Woman · non-mydriatic acquisition · axial length (AL) 22.77 mm · intraocular pressure 10 mmHg · pachymetry: 493 µm · FOV: 30 degrees · acquired with a Topcon TRC-NW400 · age 67: 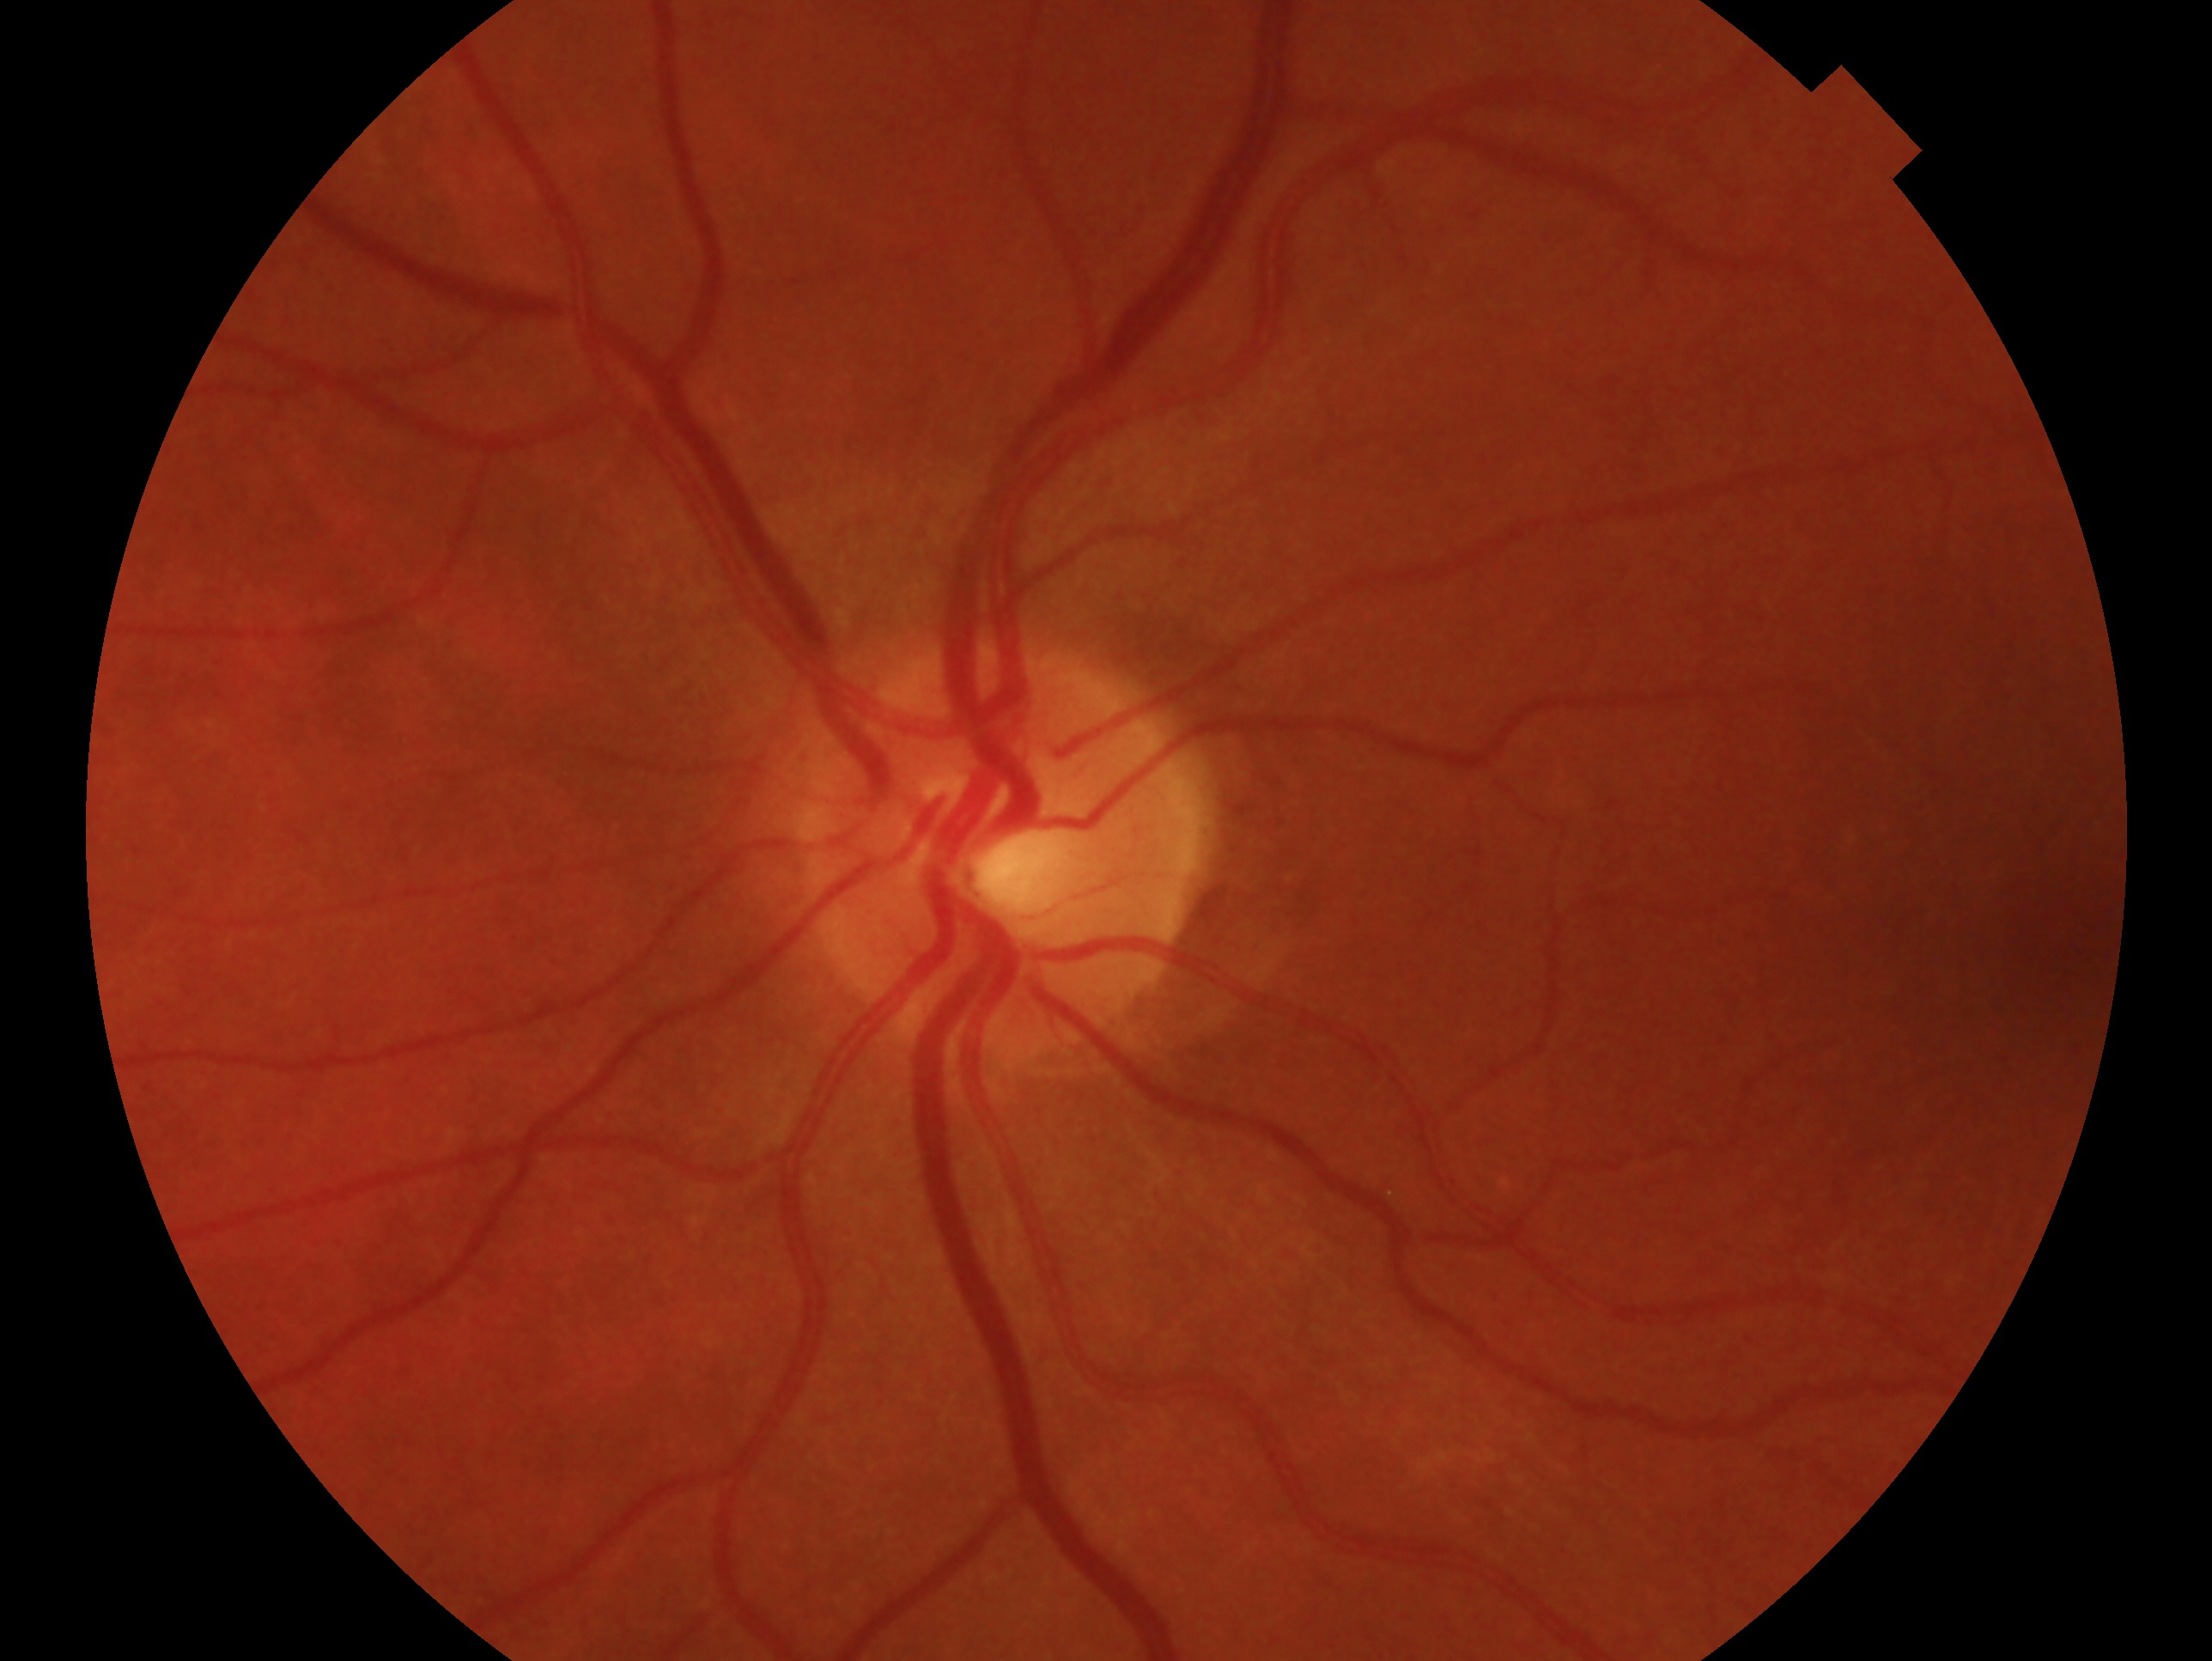 Diagnosis: negative for glaucoma — no clinical evidence of glaucoma in this eye.
This is the left eye.